NIDEK AFC-230 · graded on the modified Davis scale: 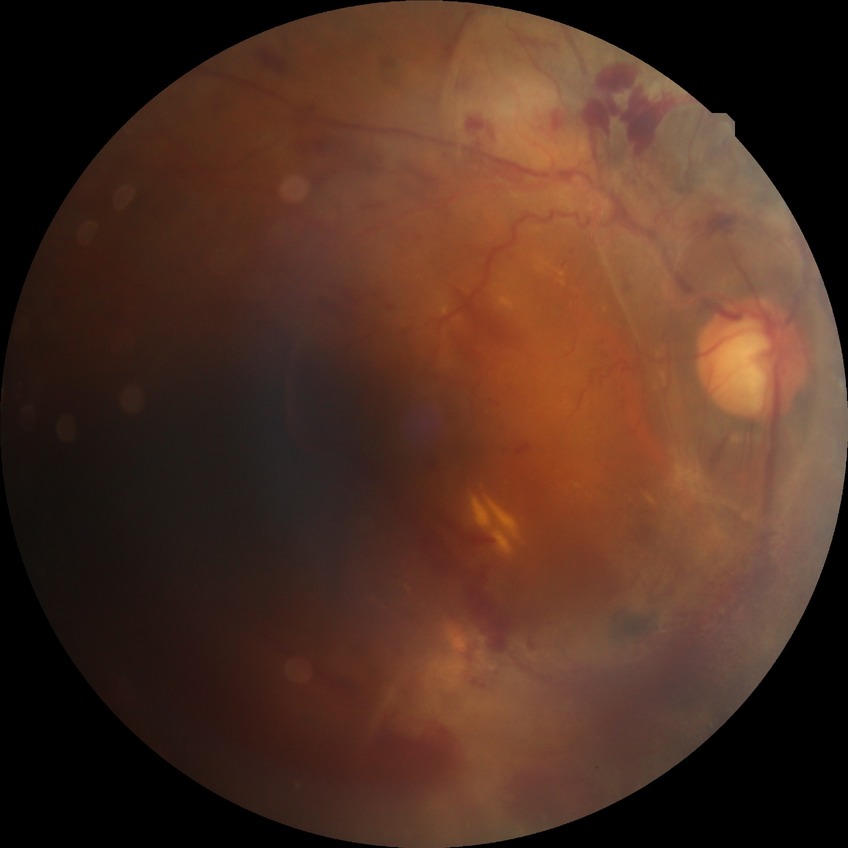

DR severity is PDR.